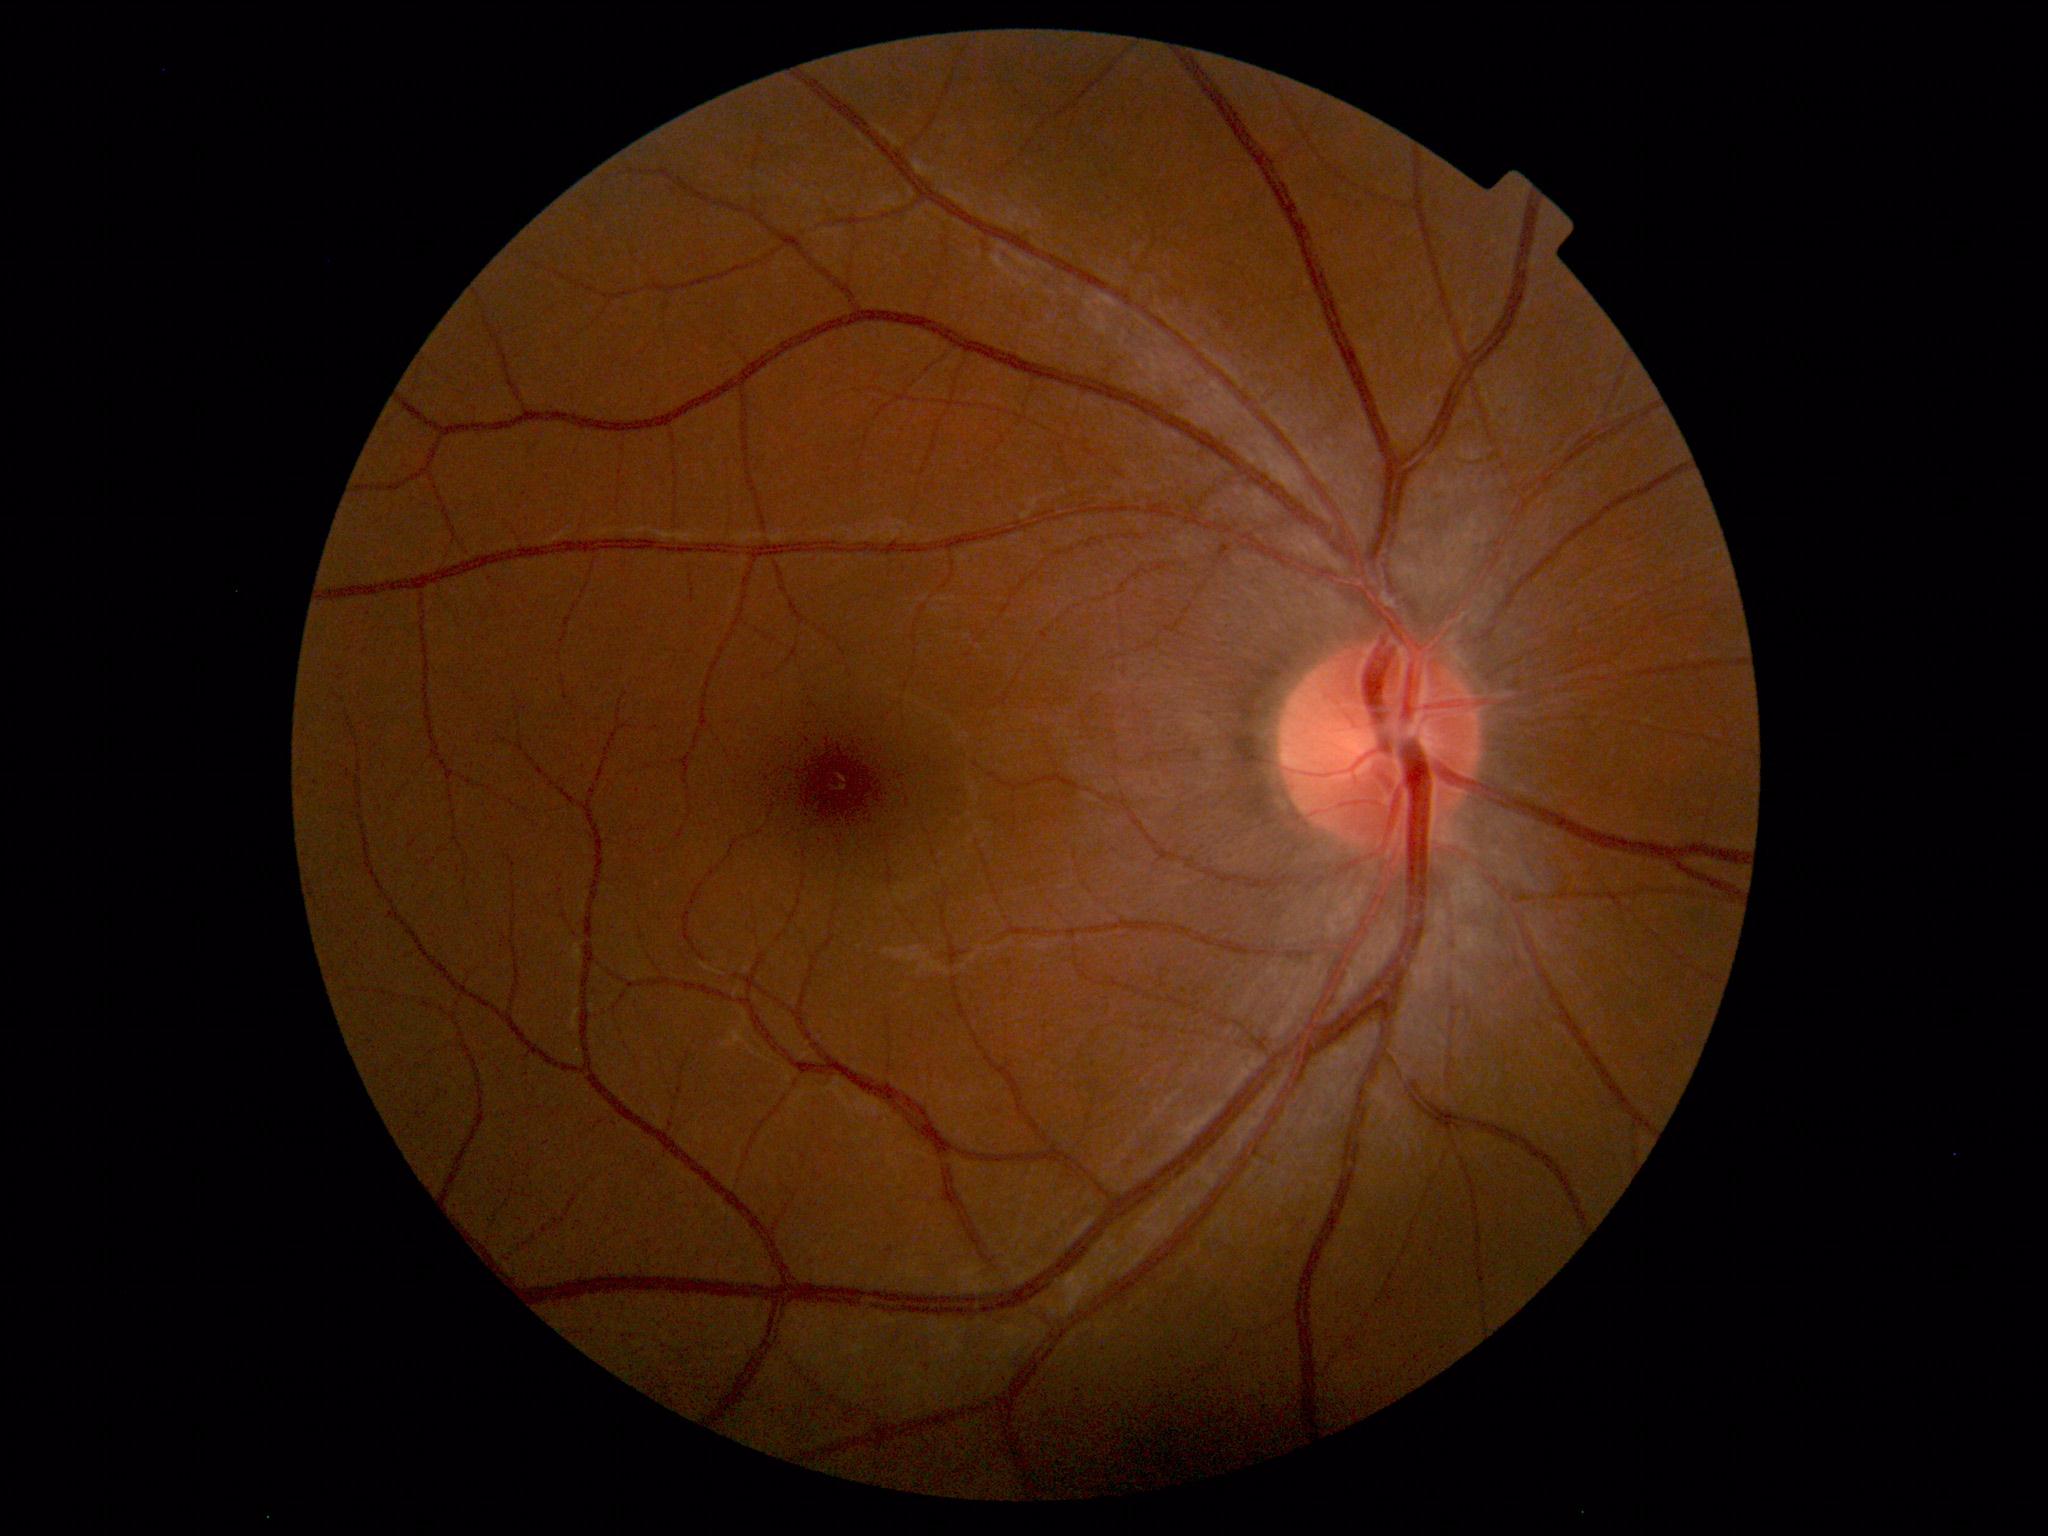
Normal retinal fundus image with no abnormalities identified.